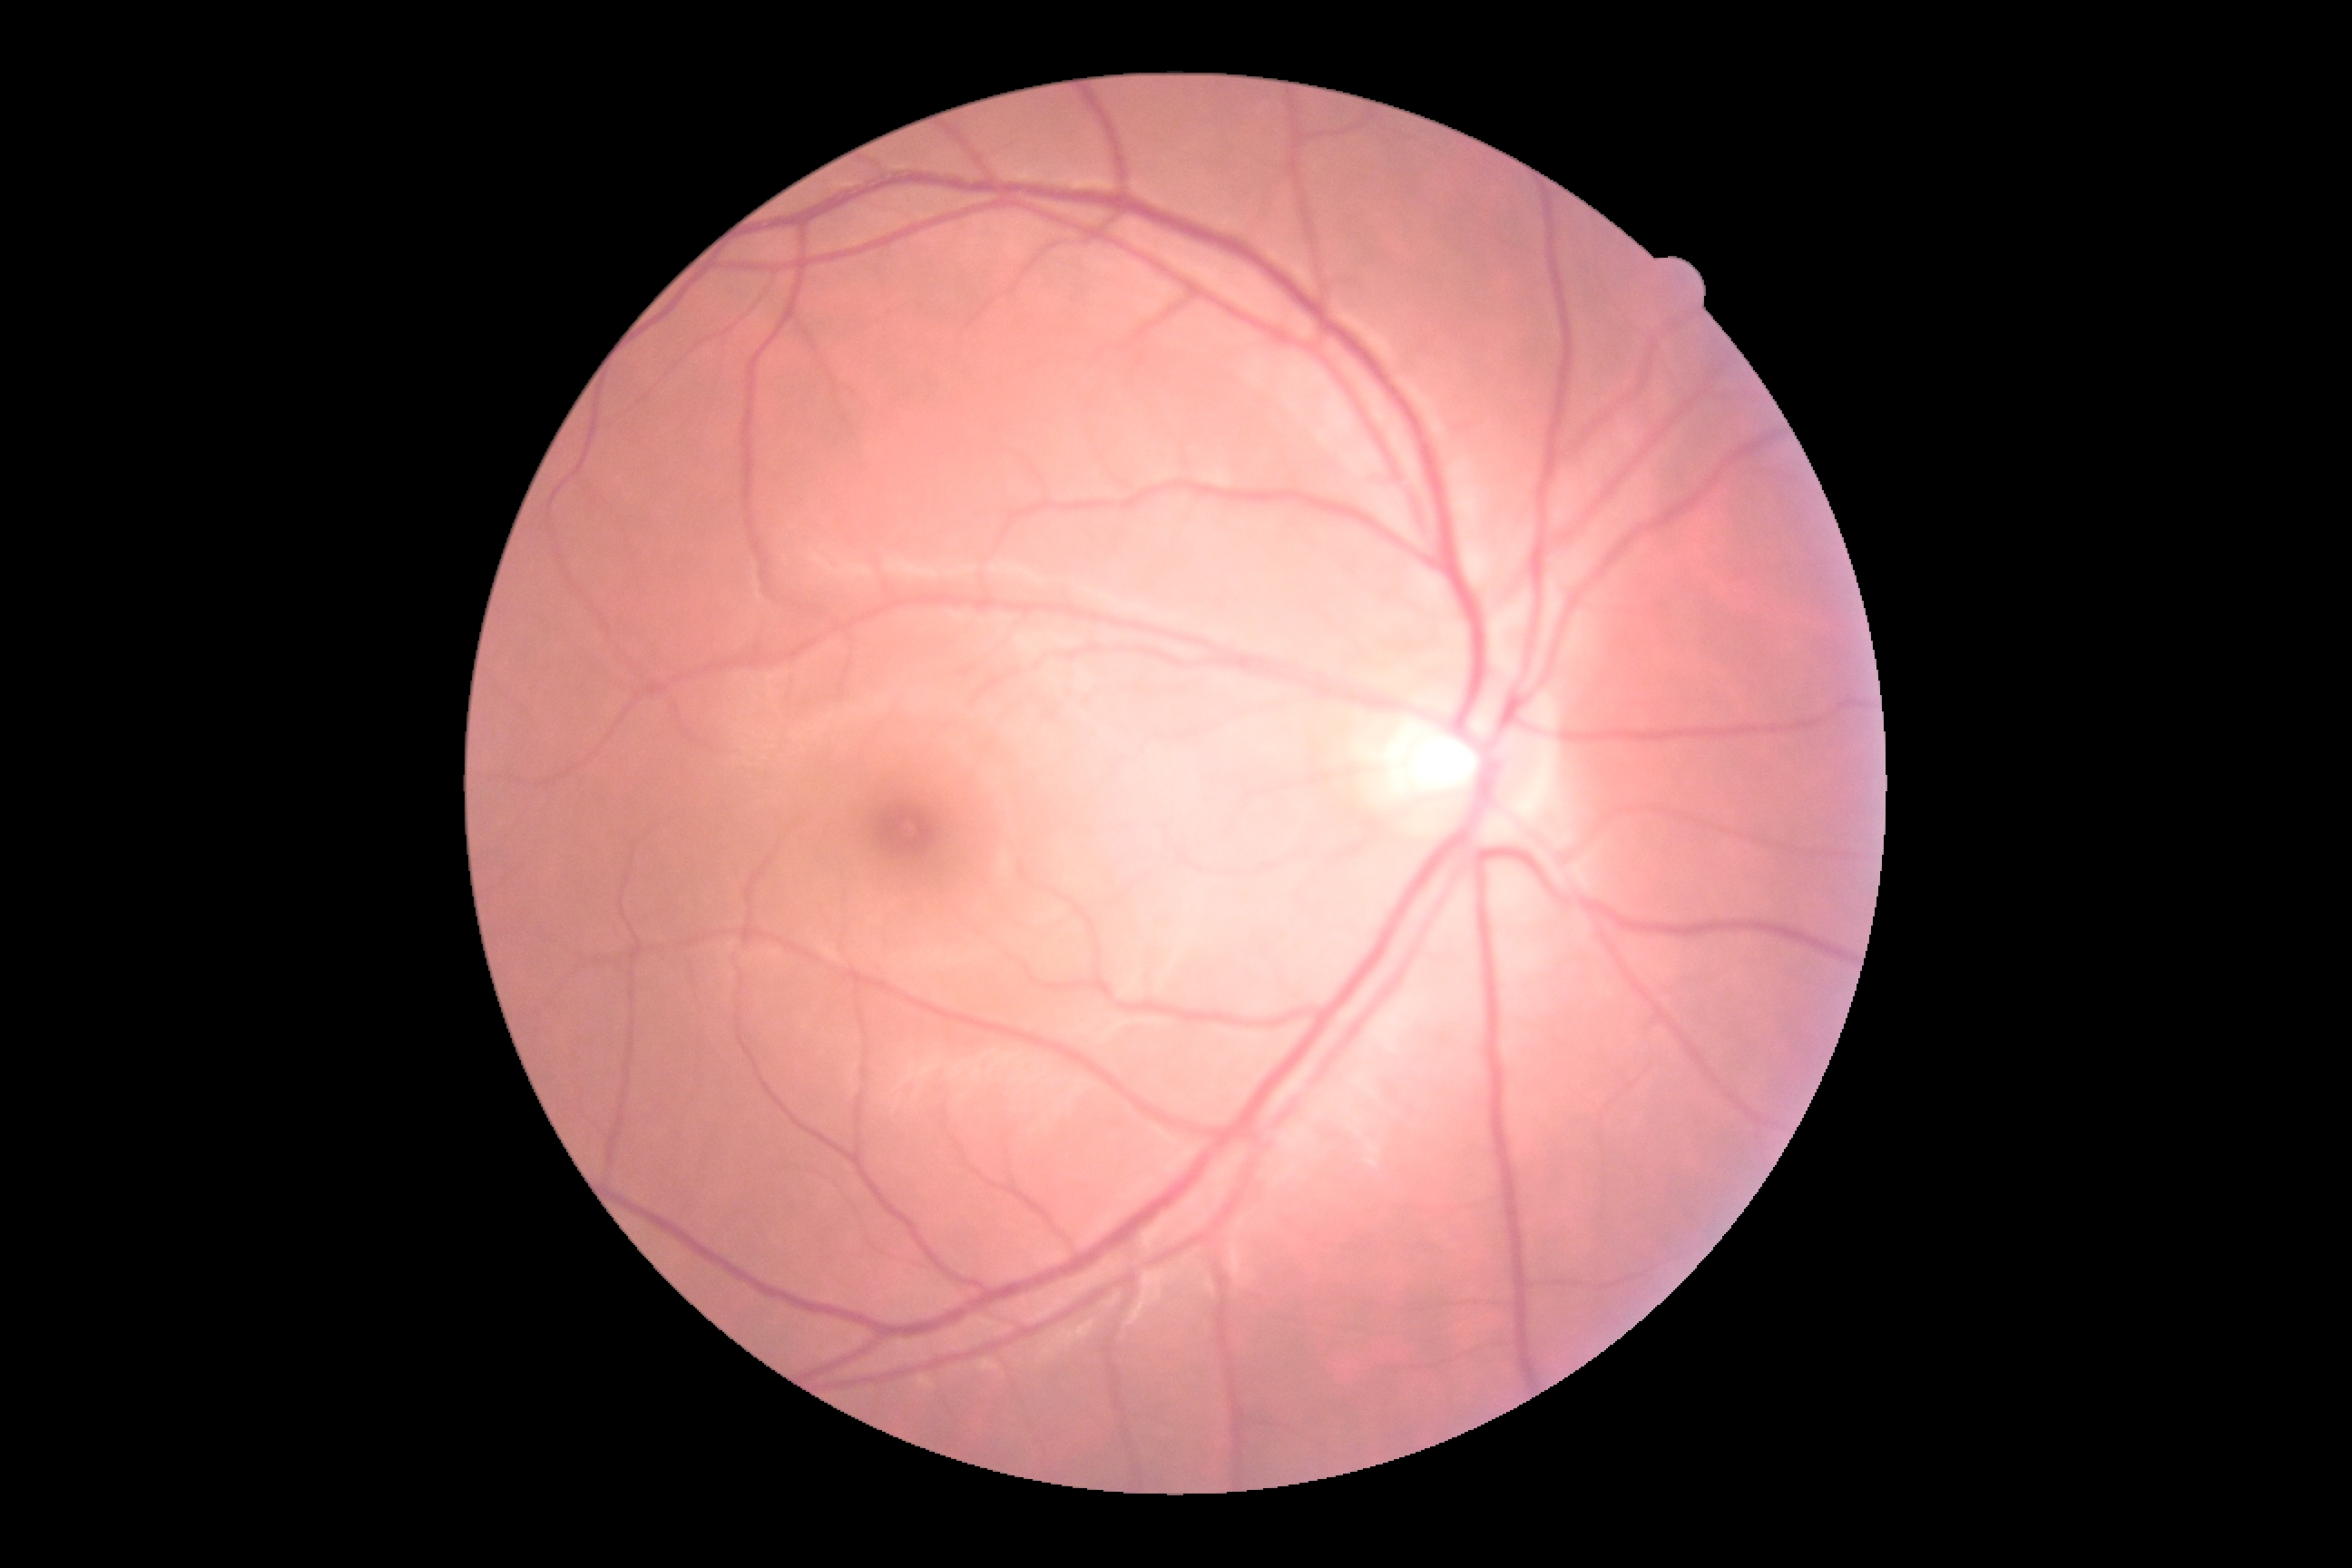

Diabetic retinopathy (DR) is no apparent diabetic retinopathy (grade 0).